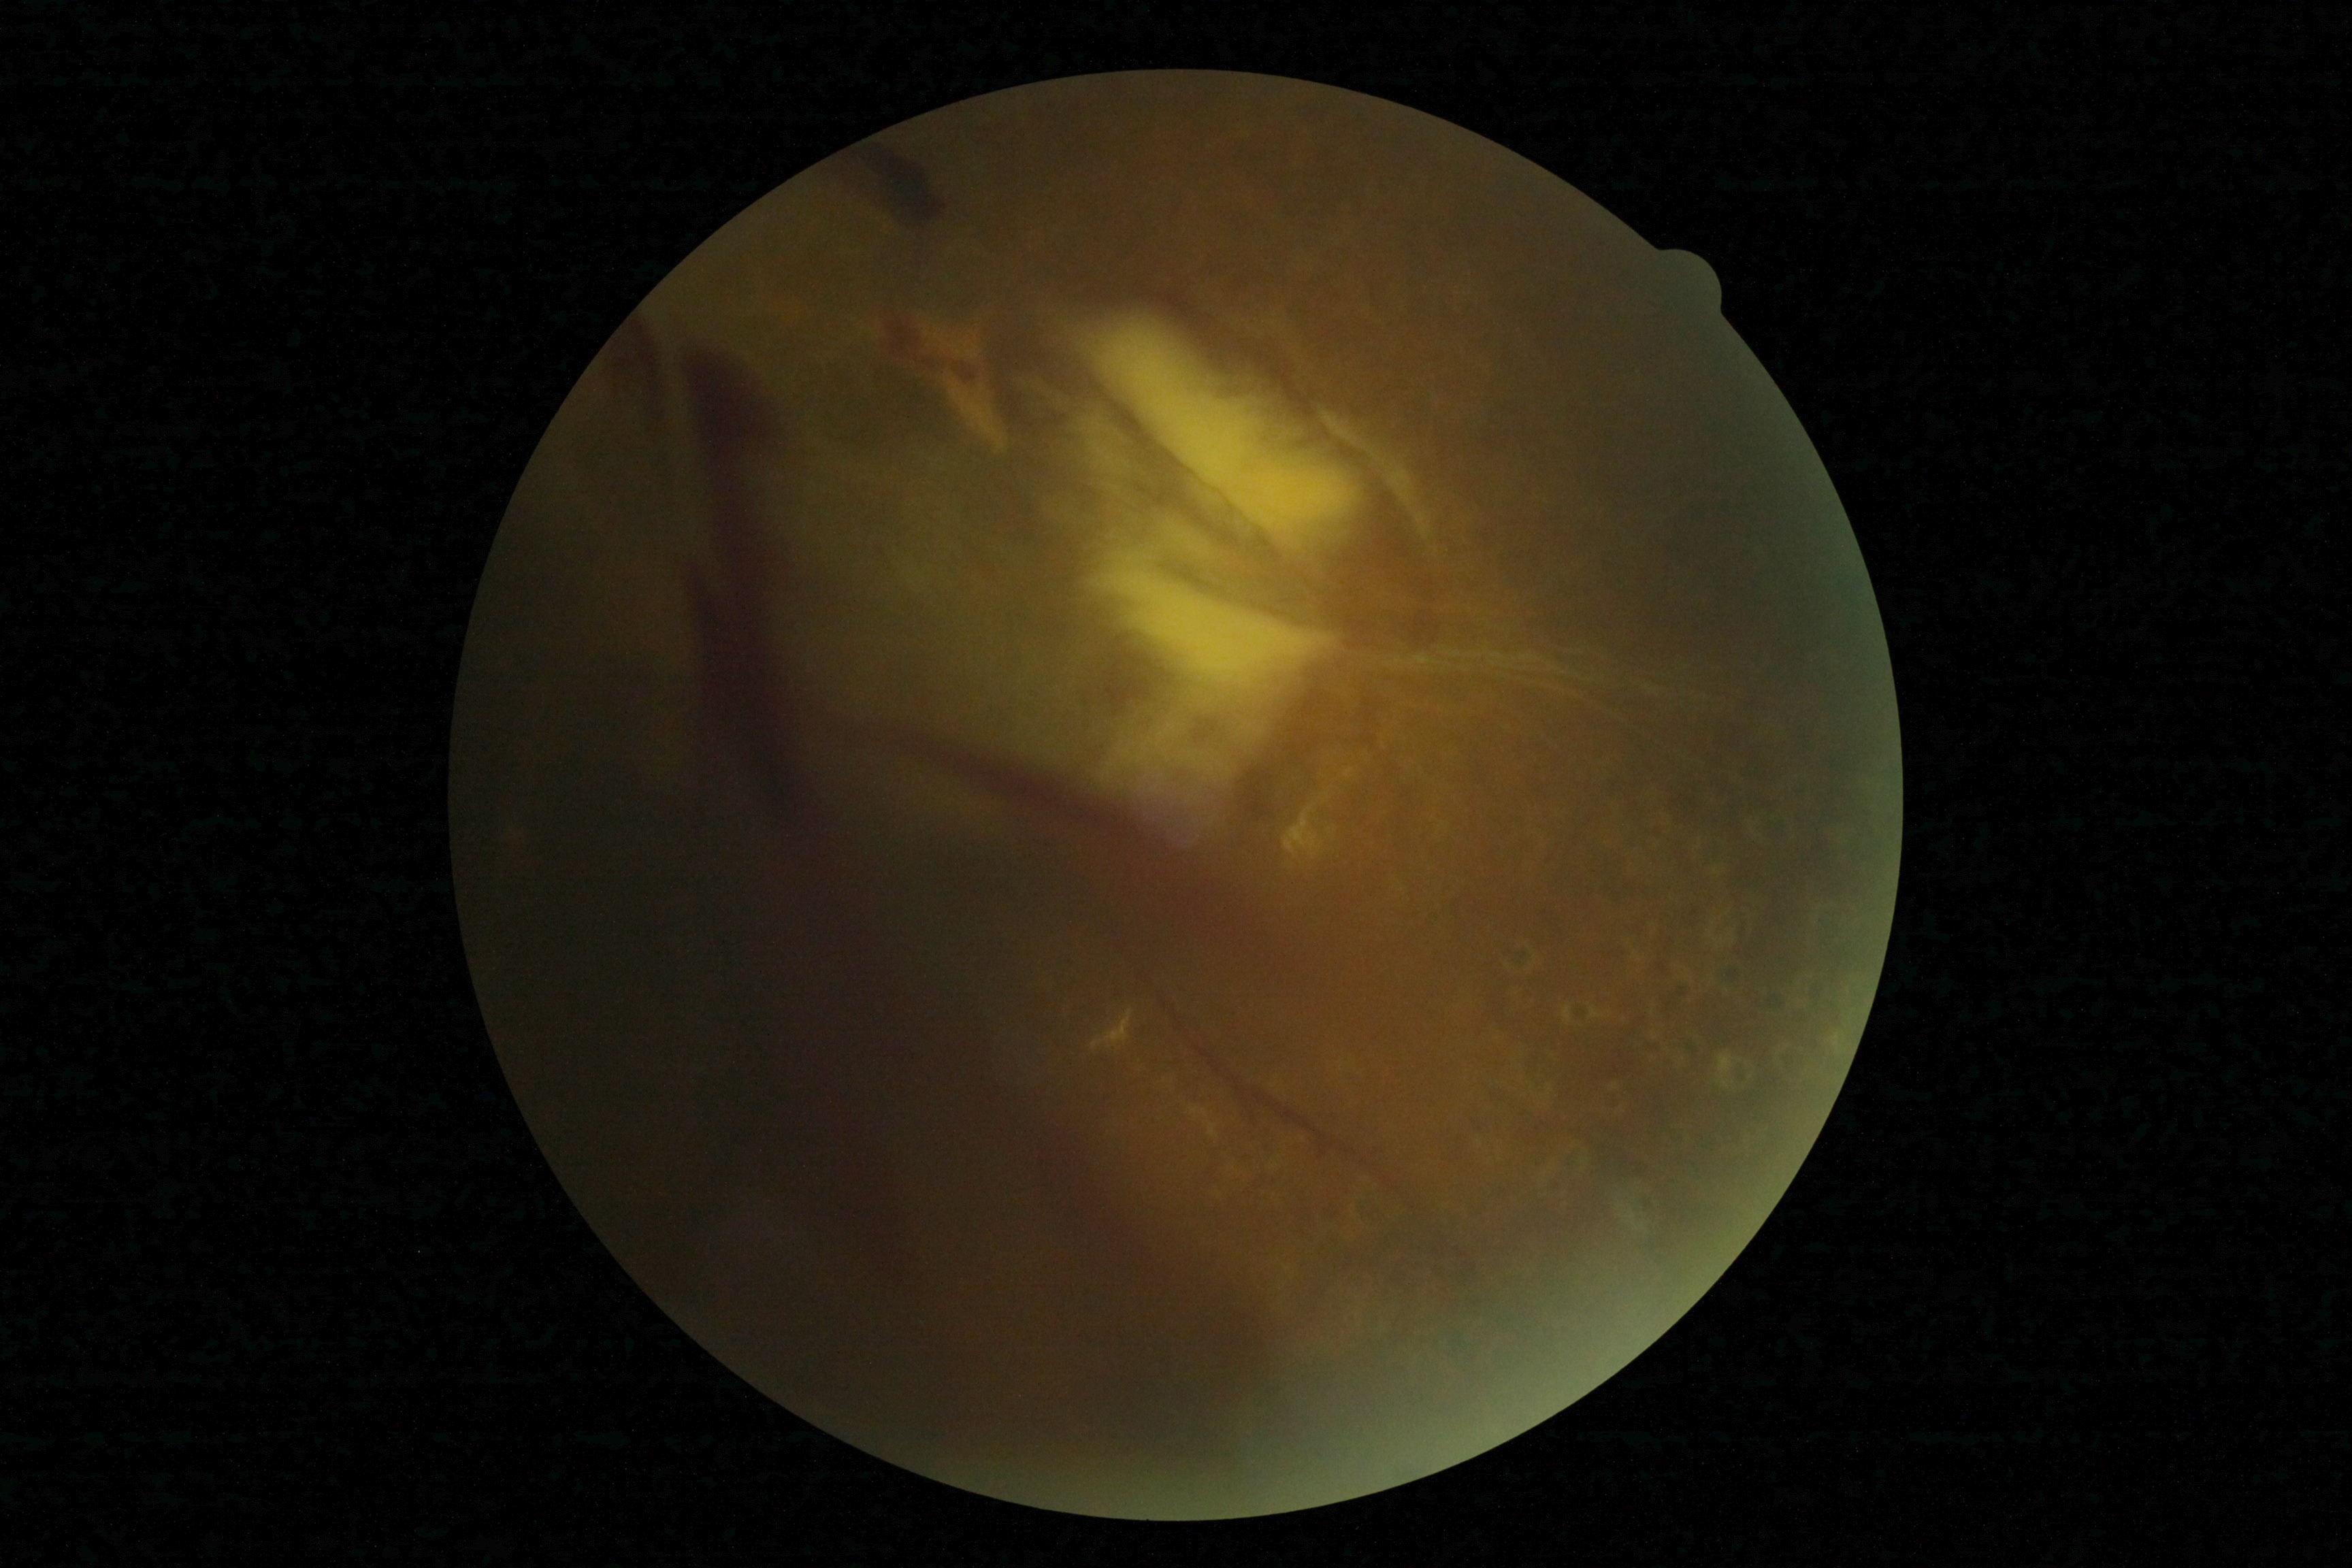 {
  "dr_grade": "grade 4"
}